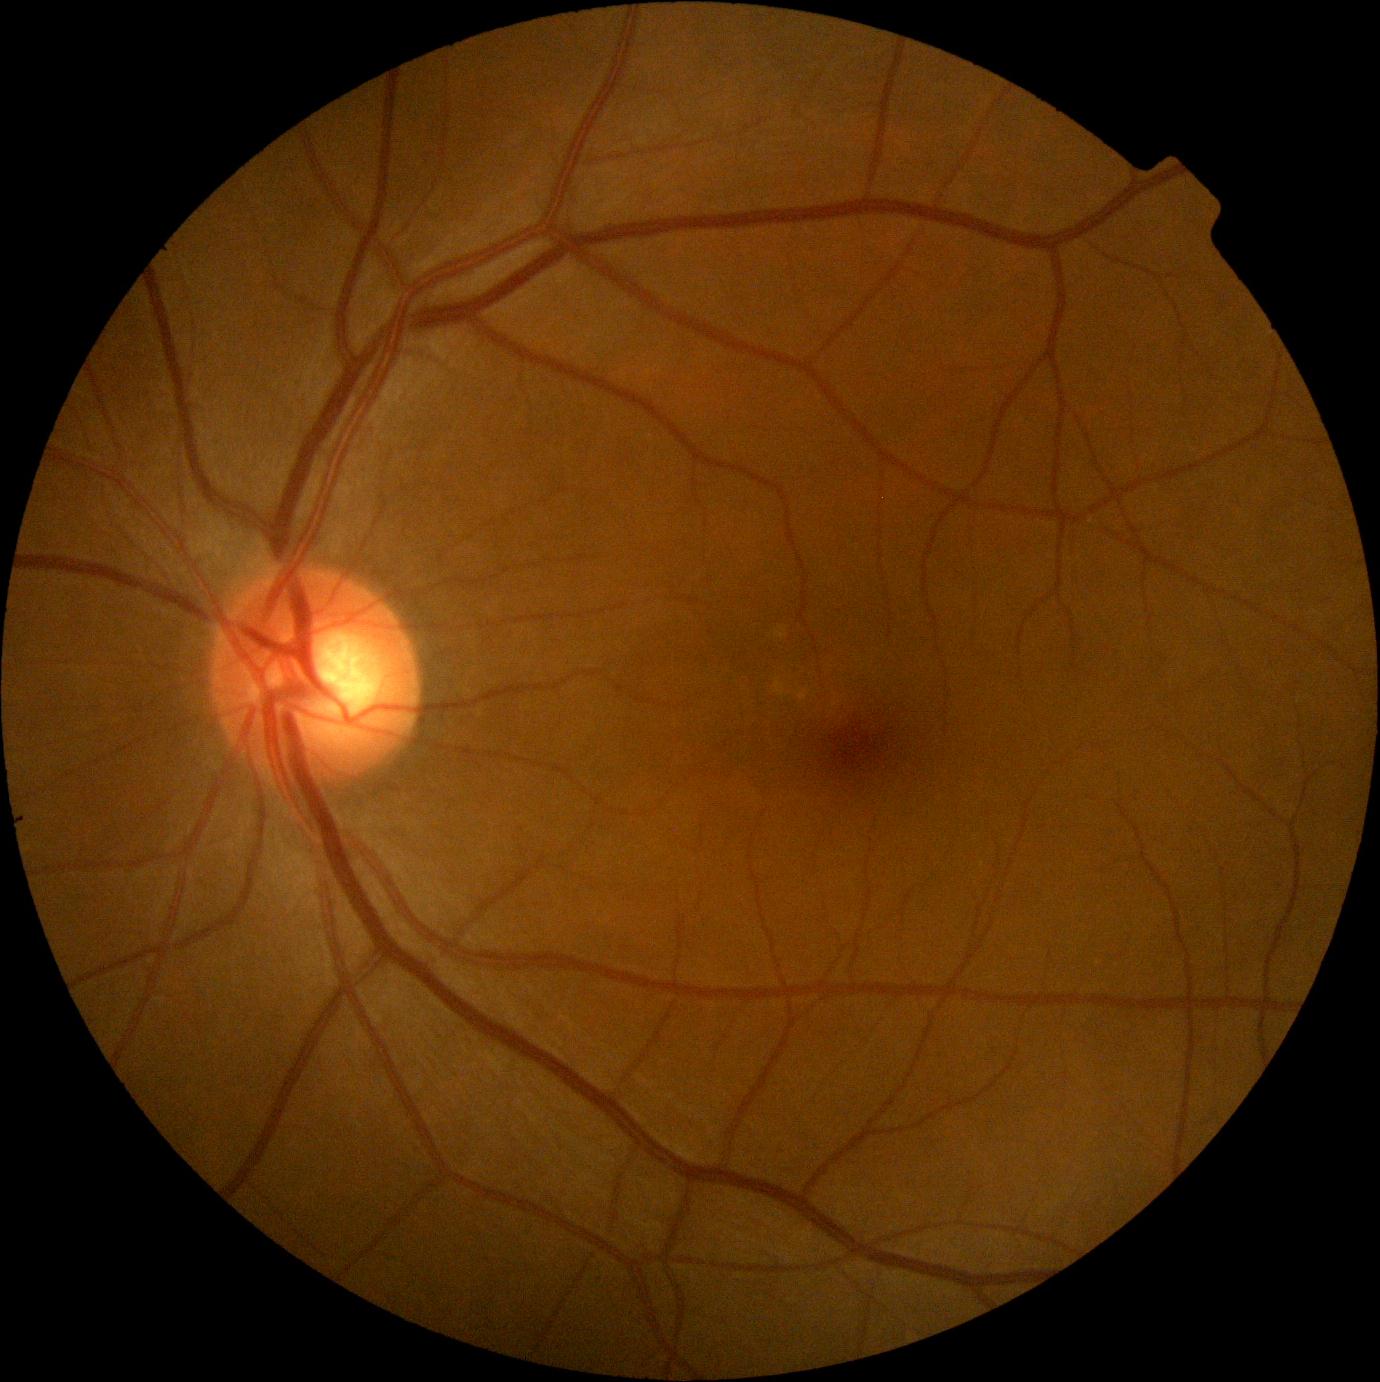

No DR findings. Retinopathy is no apparent diabetic retinopathy (grade 0).